CFP · 2352 x 1568 pixels.
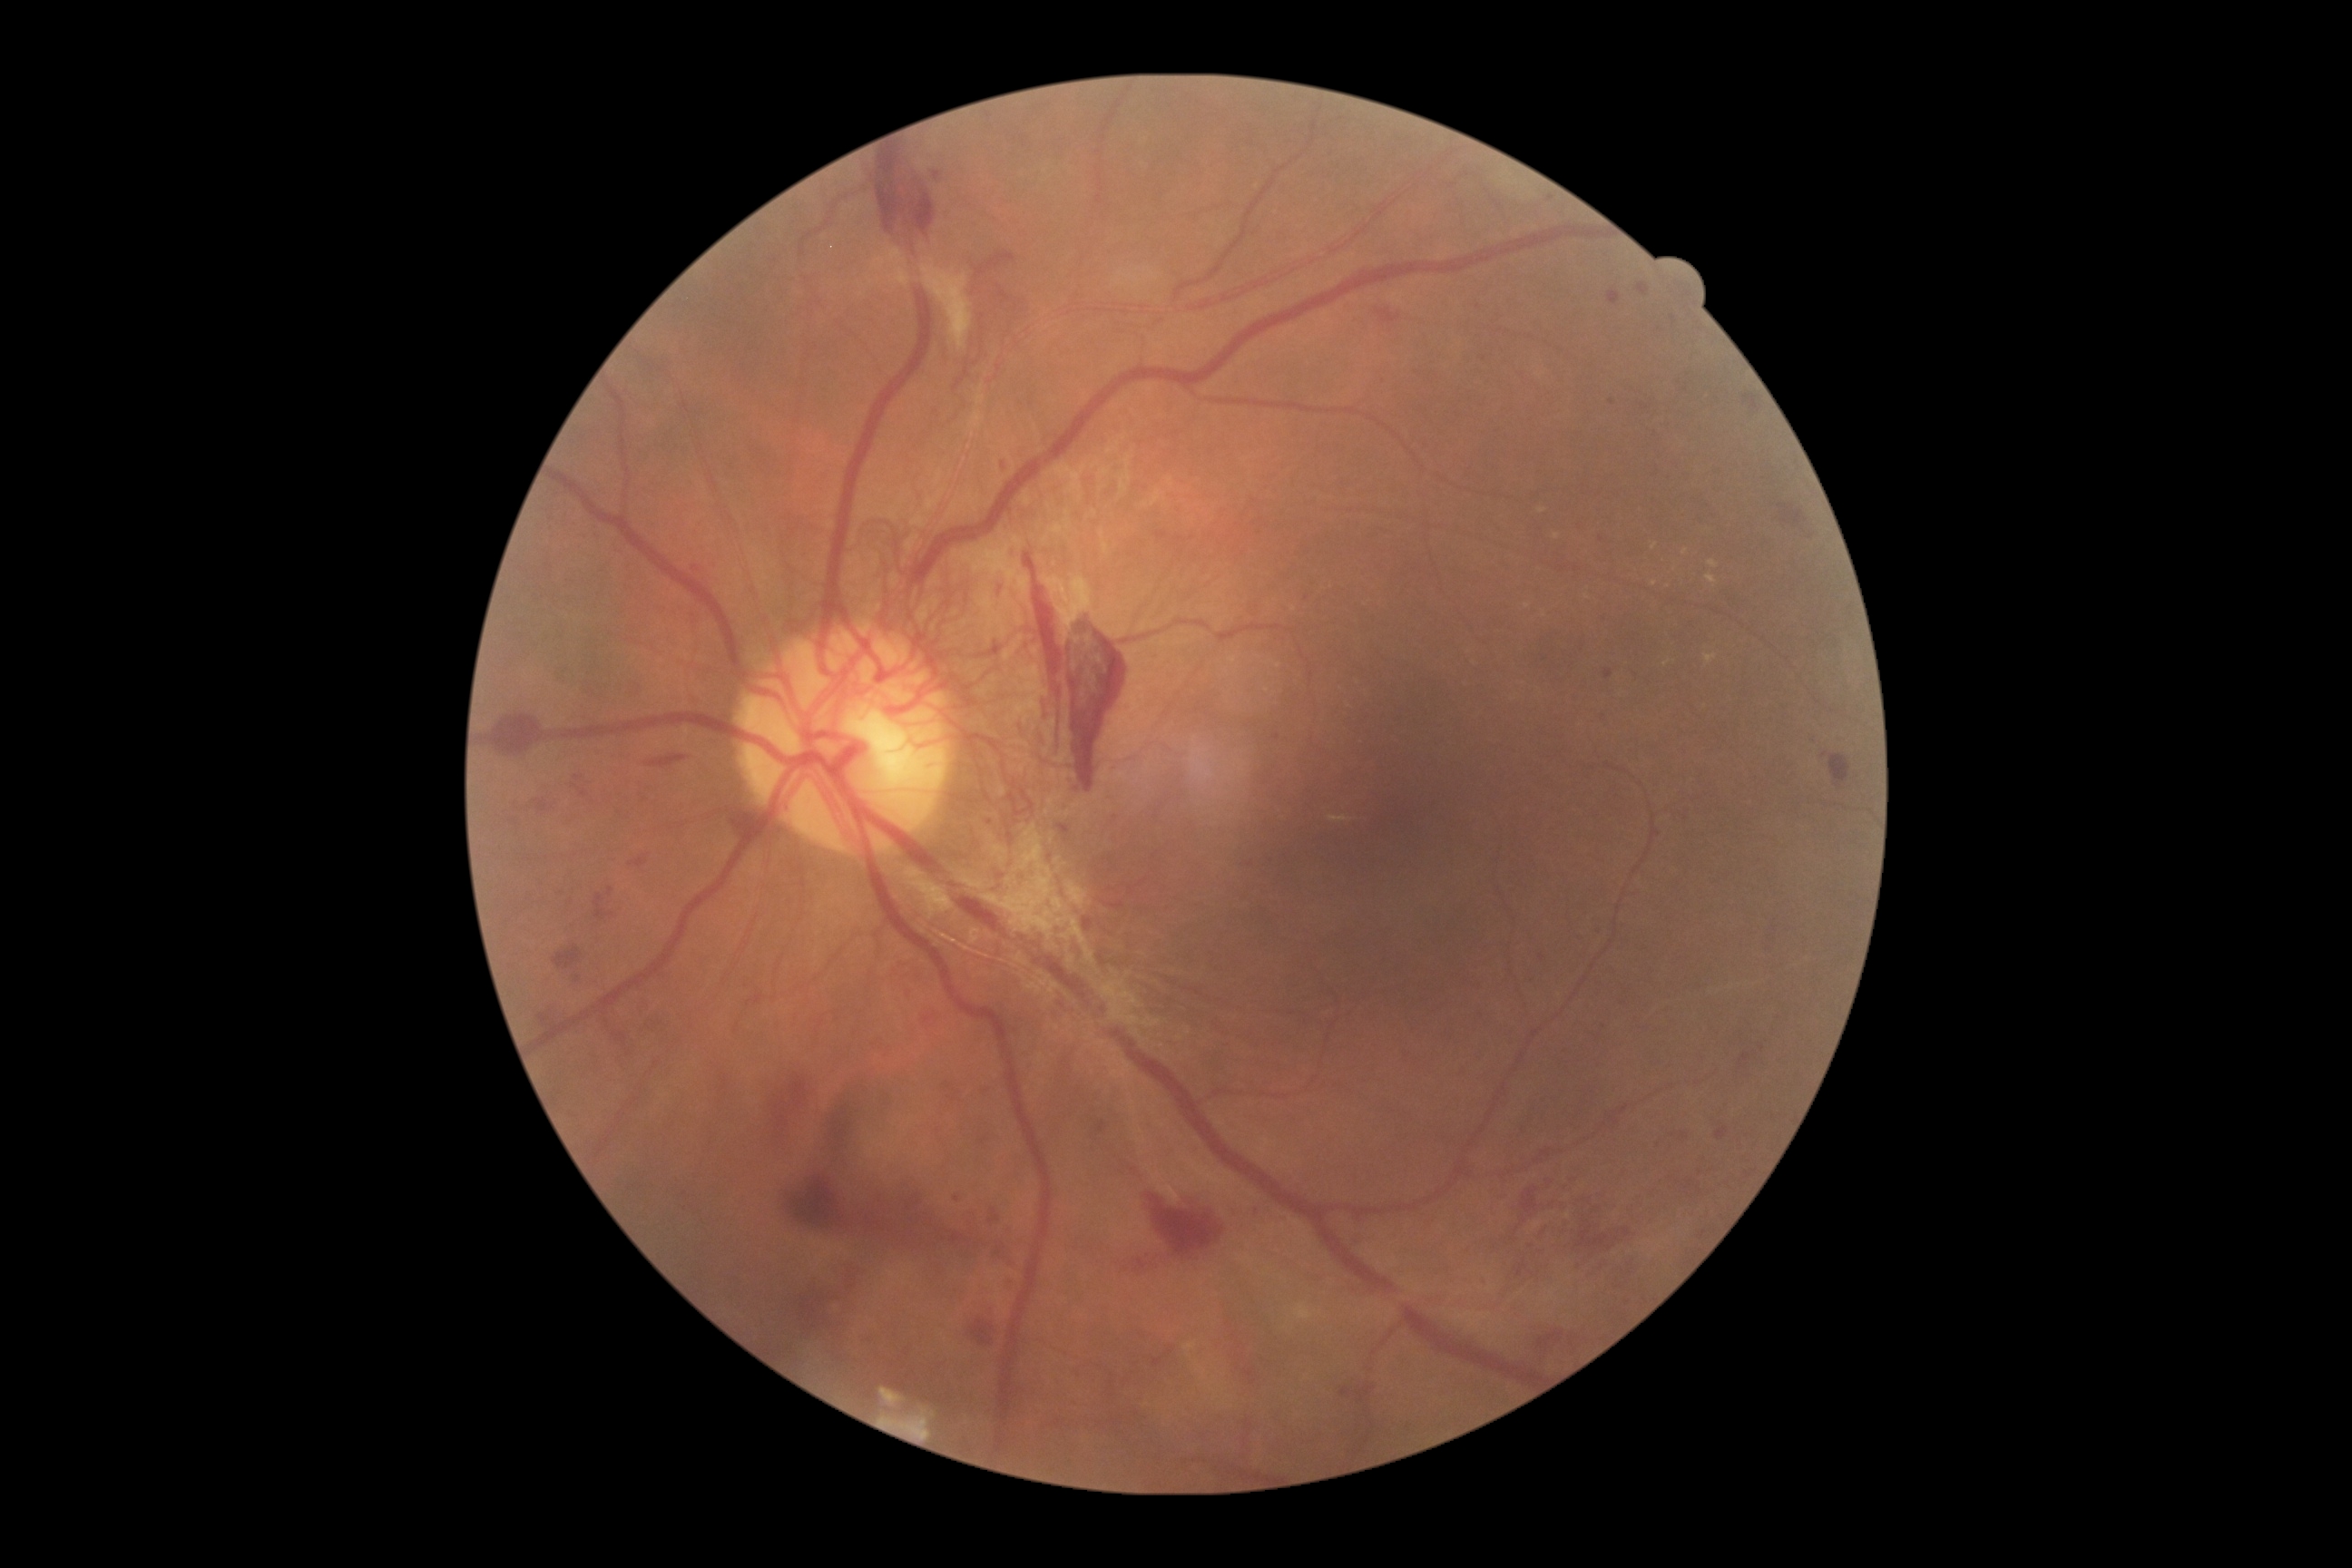
Diabetic retinopathy is proliferative diabetic retinopathy (grade 4) — neovascularization and/or vitreous/pre-retinal hemorrhage
Representative lesions:
• microaneurysms (continued): region(1600, 536, 1605, 544) | region(747, 990, 765, 1006) | region(573, 974, 582, 985) | region(1698, 1231, 1707, 1239) | region(932, 172, 943, 182) | region(691, 565, 703, 574) | region(1155, 531, 1170, 542) | region(1808, 534, 1816, 540) | region(1642, 404, 1652, 411) | region(1607, 289, 1622, 308) | region(1636, 282, 1649, 299)
• Smaller microaneurysms around <pt>571,902</pt> | <pt>1257,1211</pt> | <pt>1545,659</pt> | <pt>1062,1006</pt>
• hard exudates (continued): region(1663, 660, 1671, 667) | region(1538, 507, 1547, 513) | region(1707, 574, 1718, 585) | region(1709, 562, 1720, 569) | region(1705, 654, 1718, 667)
• Smaller hard exudates around <pt>1556,537</pt> | <pt>1527,606</pt> | <pt>1655,547</pt> | <pt>1686,551</pt> | <pt>1587,598</pt> | <pt>1655,583</pt>
• soft exudates: none
• hemorrhages (continued): region(936, 1226, 974, 1246) | region(912, 1215, 936, 1226) | region(571, 783, 589, 799) | region(1529, 1271, 1534, 1279) | region(1068, 631, 1128, 794) | region(830, 1106, 854, 1148) | region(1743, 393, 1763, 413) | region(534, 799, 554, 816) | region(975, 251, 1017, 280) | region(1215, 1411, 1255, 1482) | region(741, 812, 763, 834) | region(1024, 553, 1064, 680) | region(772, 1075, 808, 1130) | region(1569, 1335, 1580, 1351) | region(906, 1228, 917, 1237) | region(1522, 1188, 1540, 1219)
• Smaller hemorrhages around <pt>1554,1204</pt> | <pt>1370,1370</pt> | <pt>1599,1210</pt> | <pt>904,1239</pt>